200-degree field of view. Ultra-widefield fundus photograph. Image size 1924x1556 — 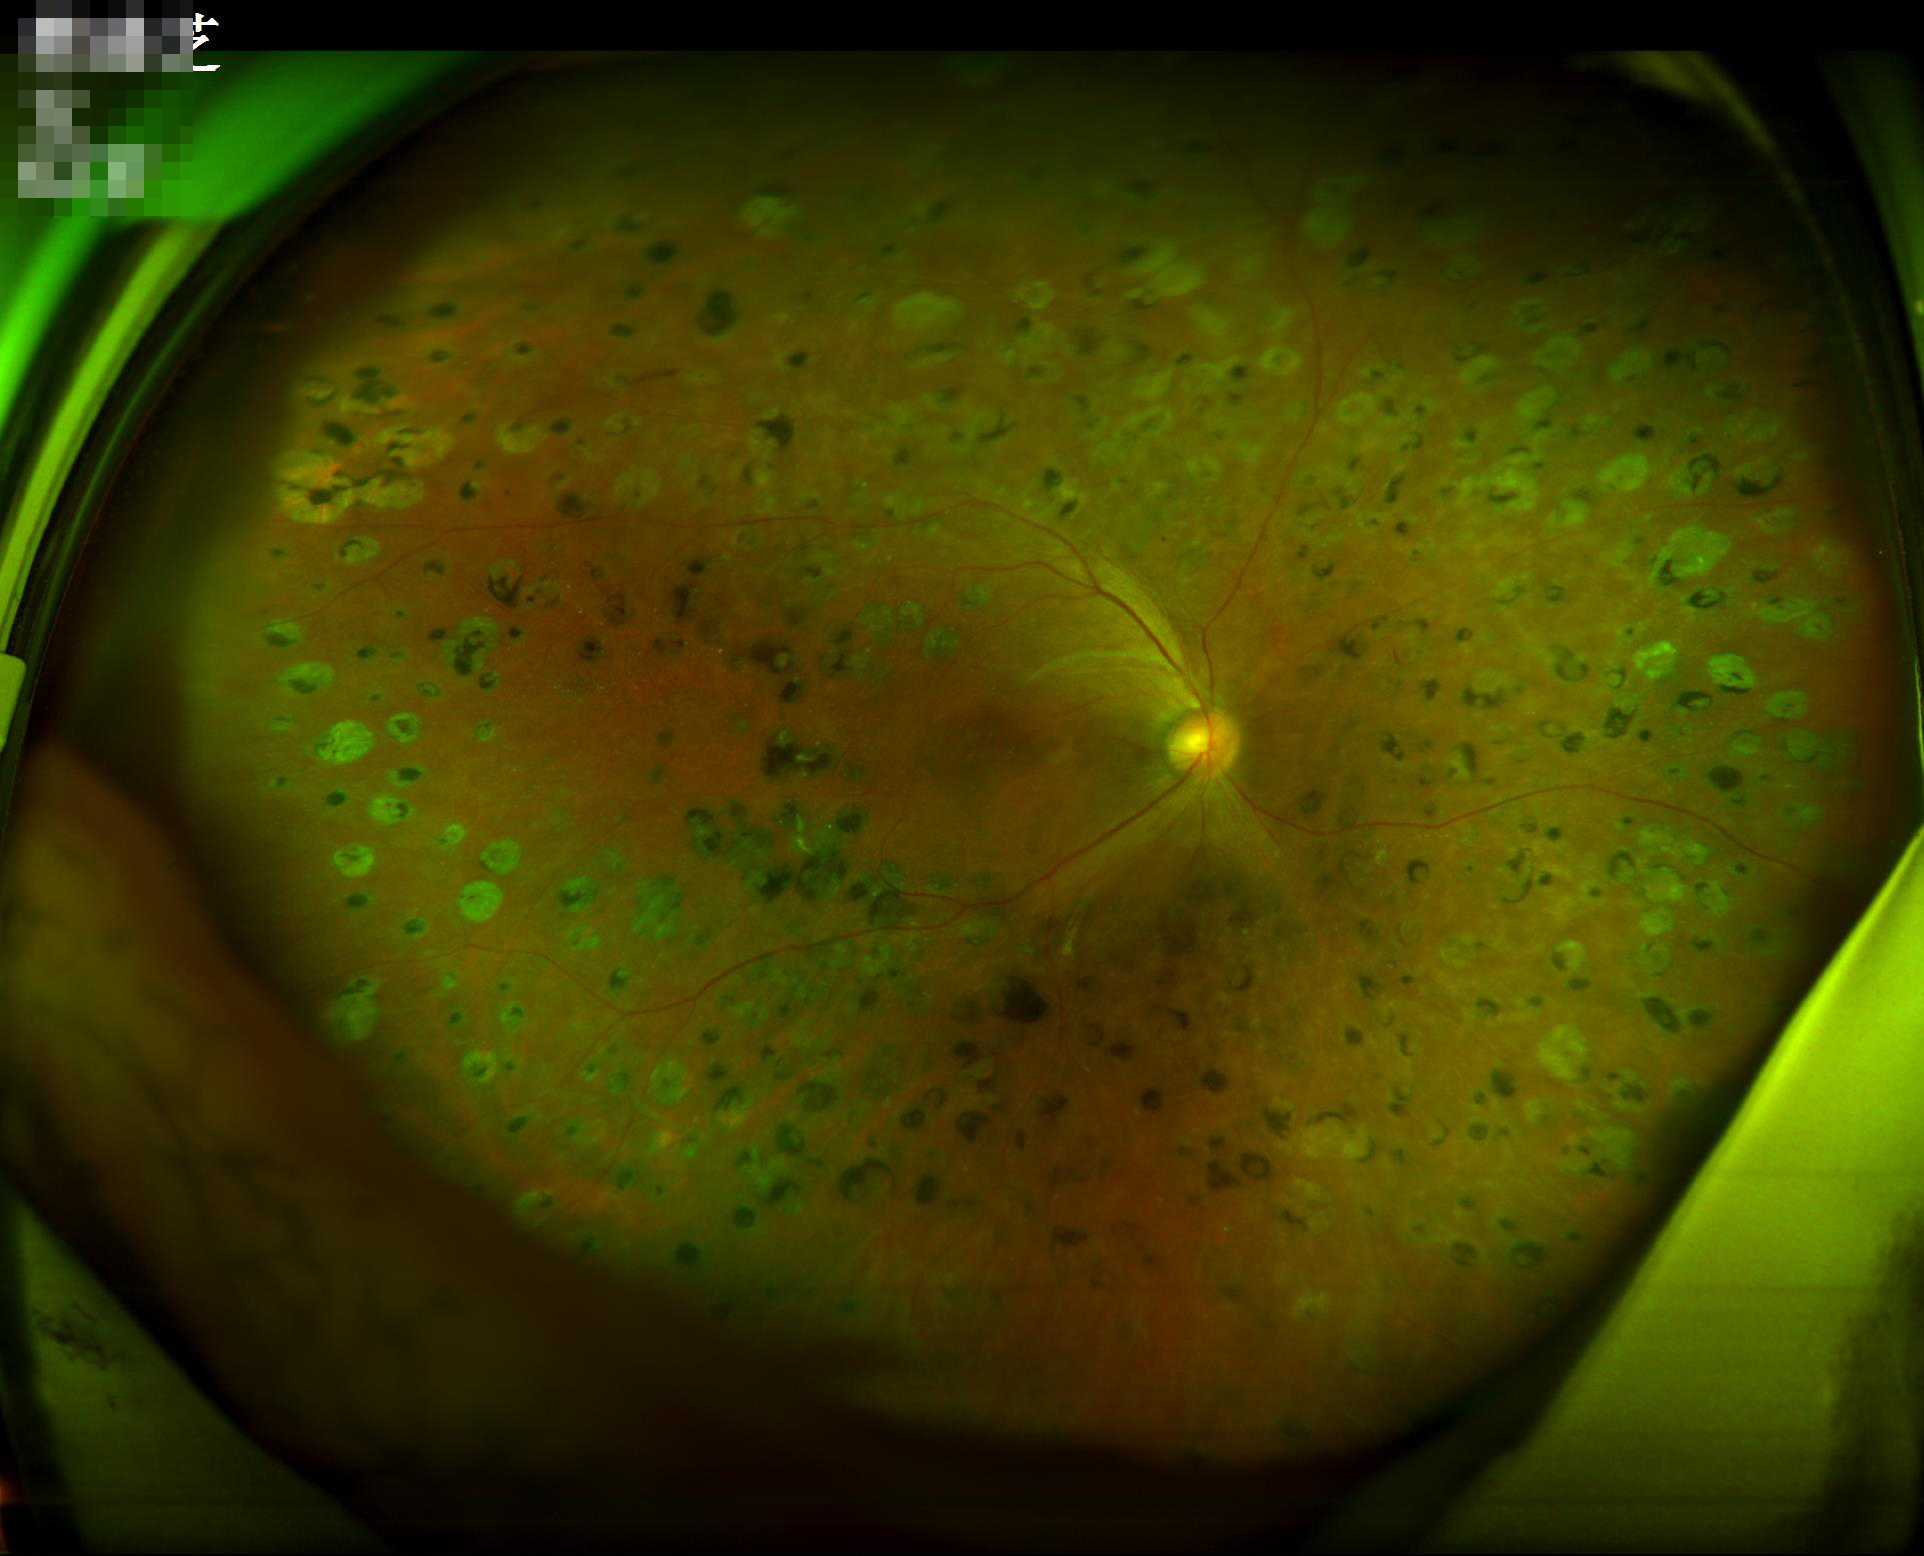
Image quality: contrast: wide intensity range, structures distinguishable | illumination/color: no over- or under-exposure | overall: adequate for clinical interpretation.